Optic disc-centered crop from a color fundus photograph — 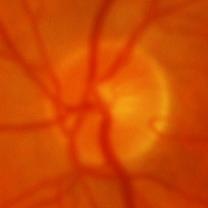 Optic disc appearance consistent with glaucoma.